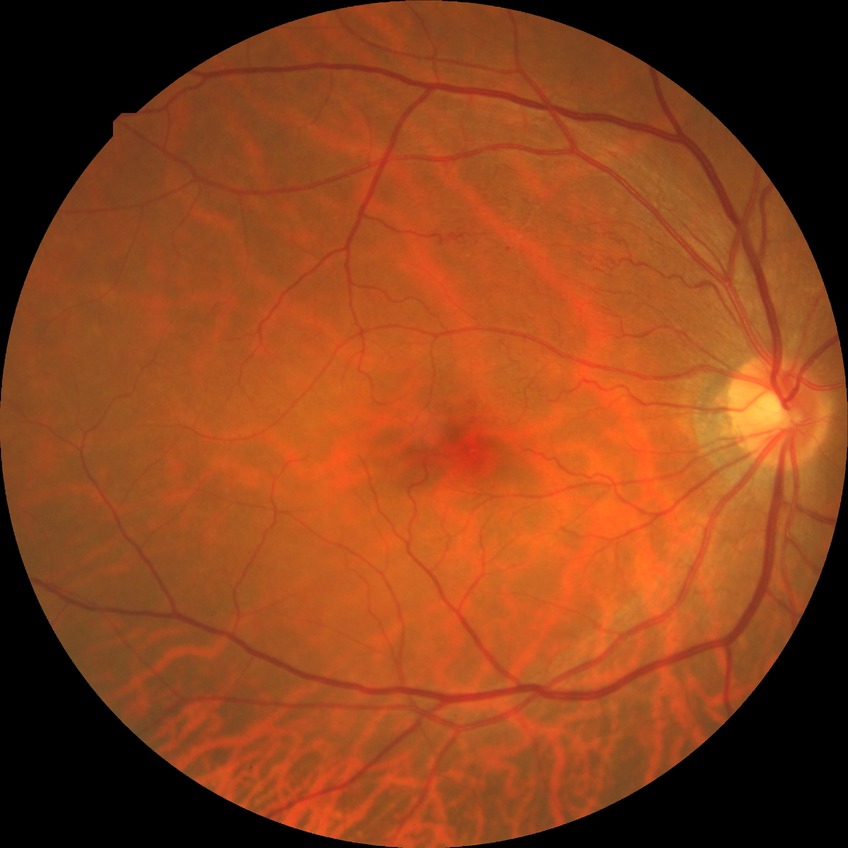
Diabetic retinopathy stage: no diabetic retinopathy.